Pediatric wide-field fundus photograph. 130° field of view (Clarity RetCam 3). 640x480: 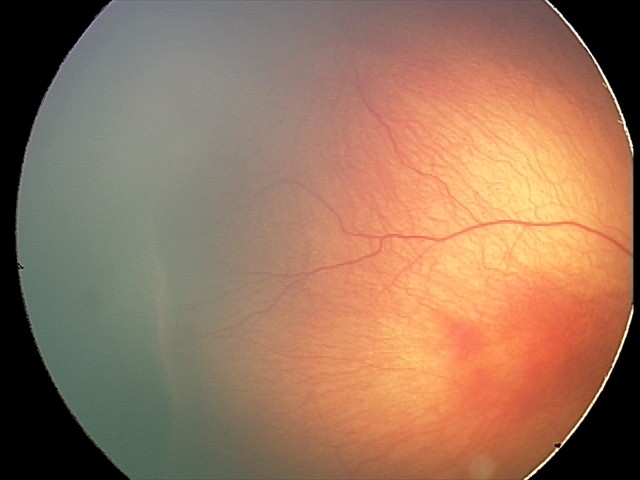 Without plus disease. Screening examination consistent with ROP stage 2.